Captured with the Phoenix ICON (100° field of view). Wide-field contact fundus photograph of an infant — 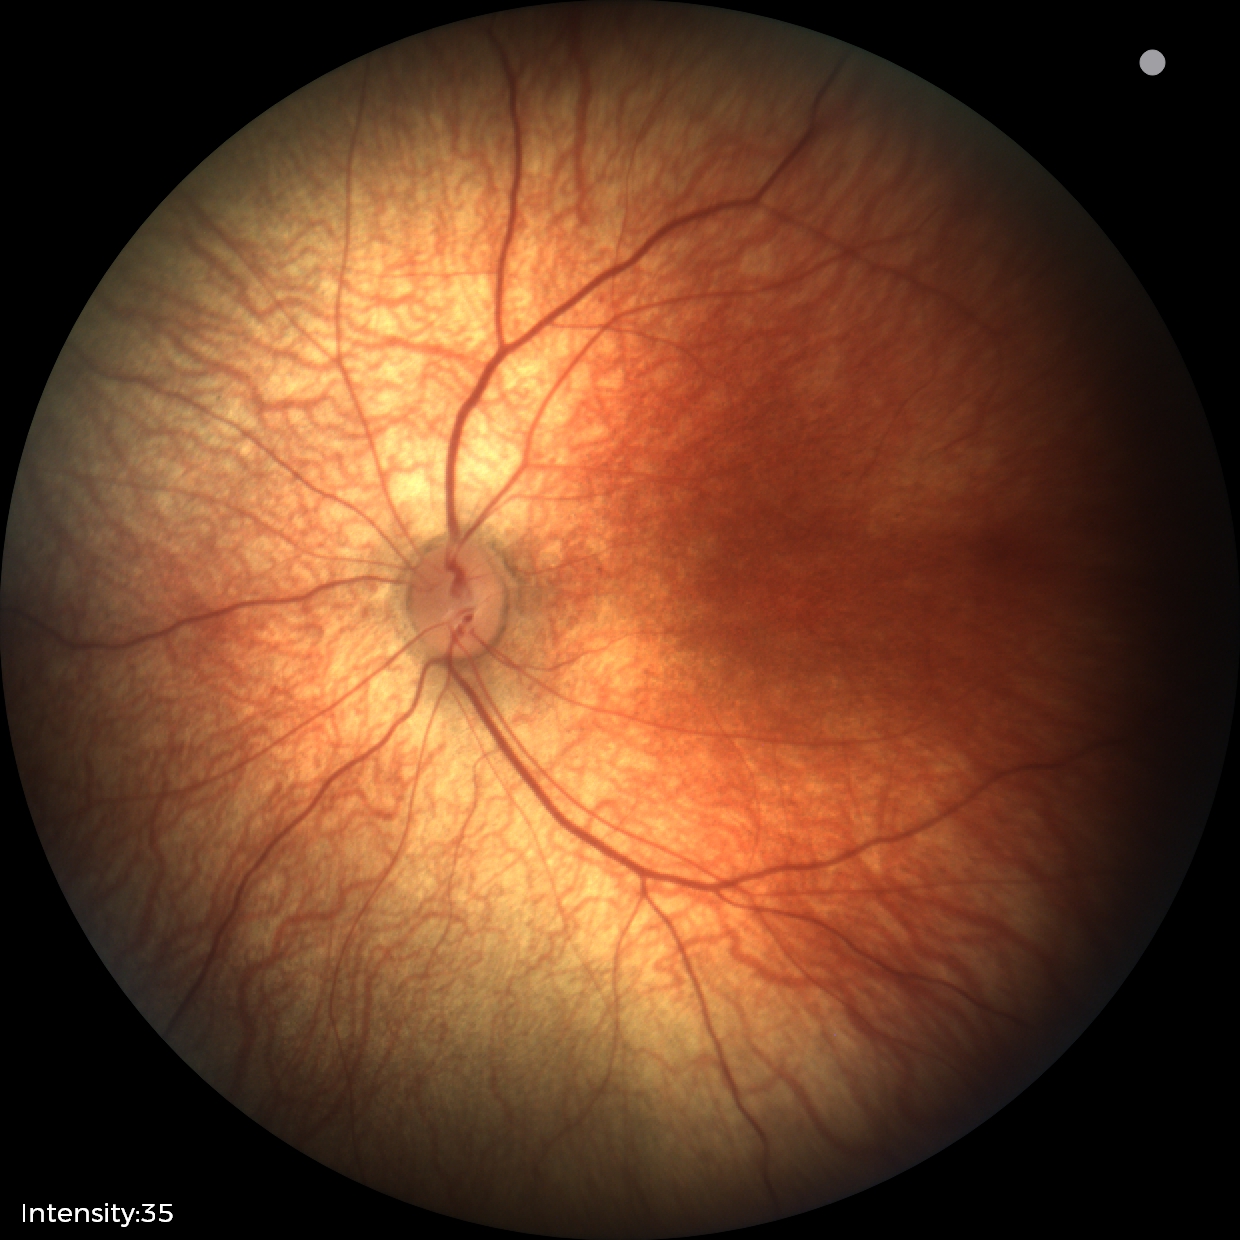
Screening examination diagnosed as physiological.